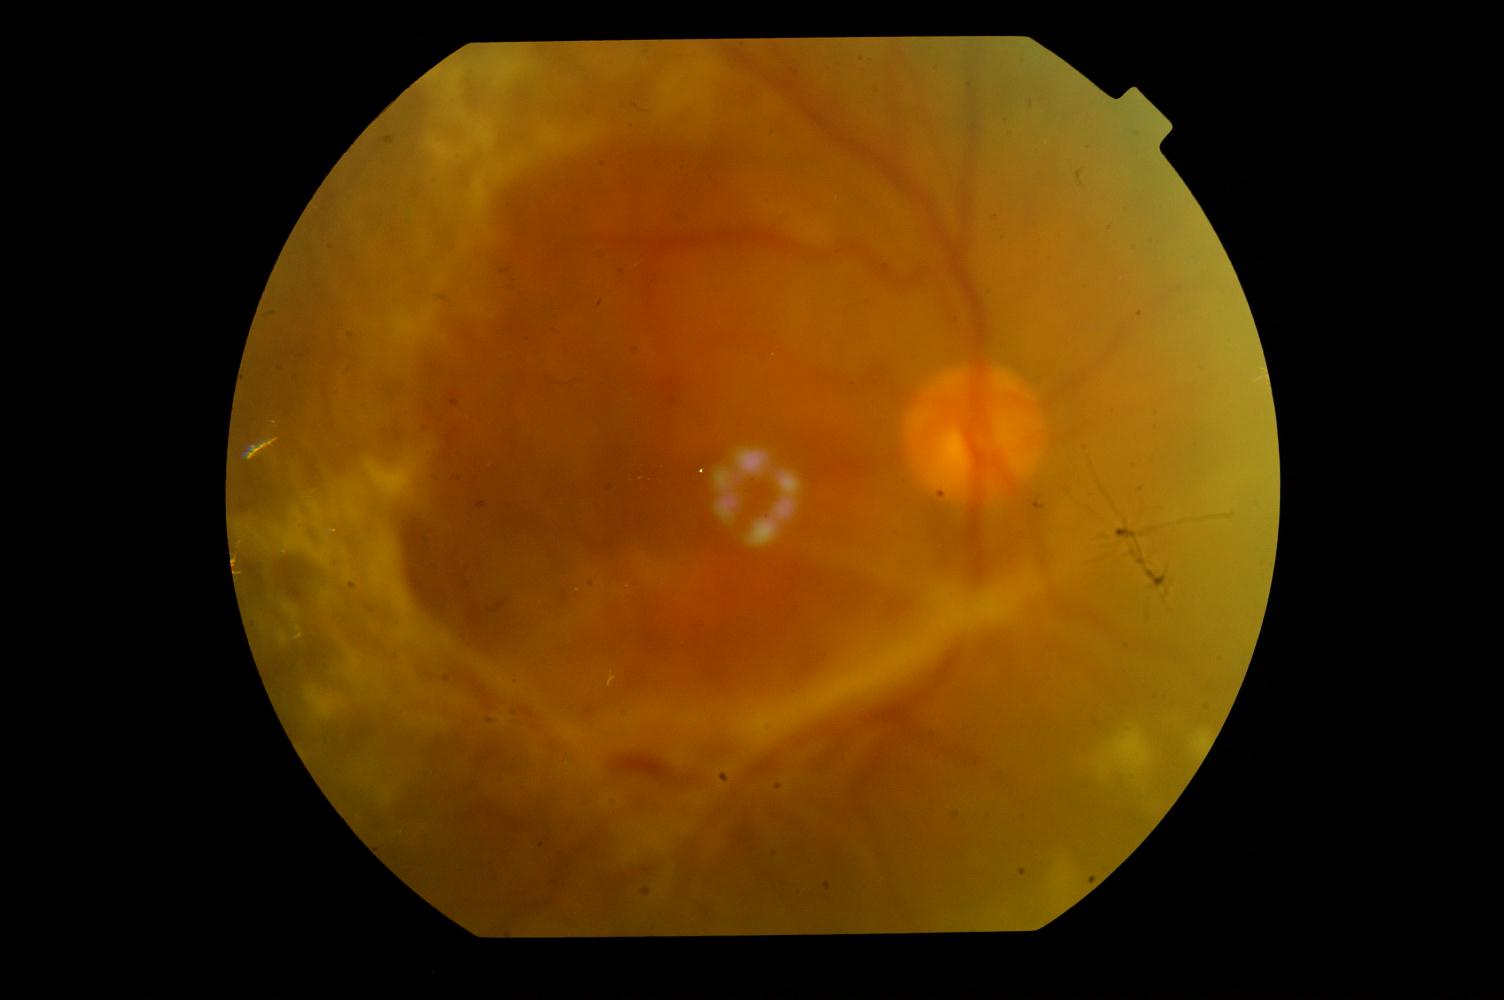
Fundus image with findings of DR (diabetic retinopathy).